Acquired on the Natus RetCam Envision · infant wide-field fundus photograph: 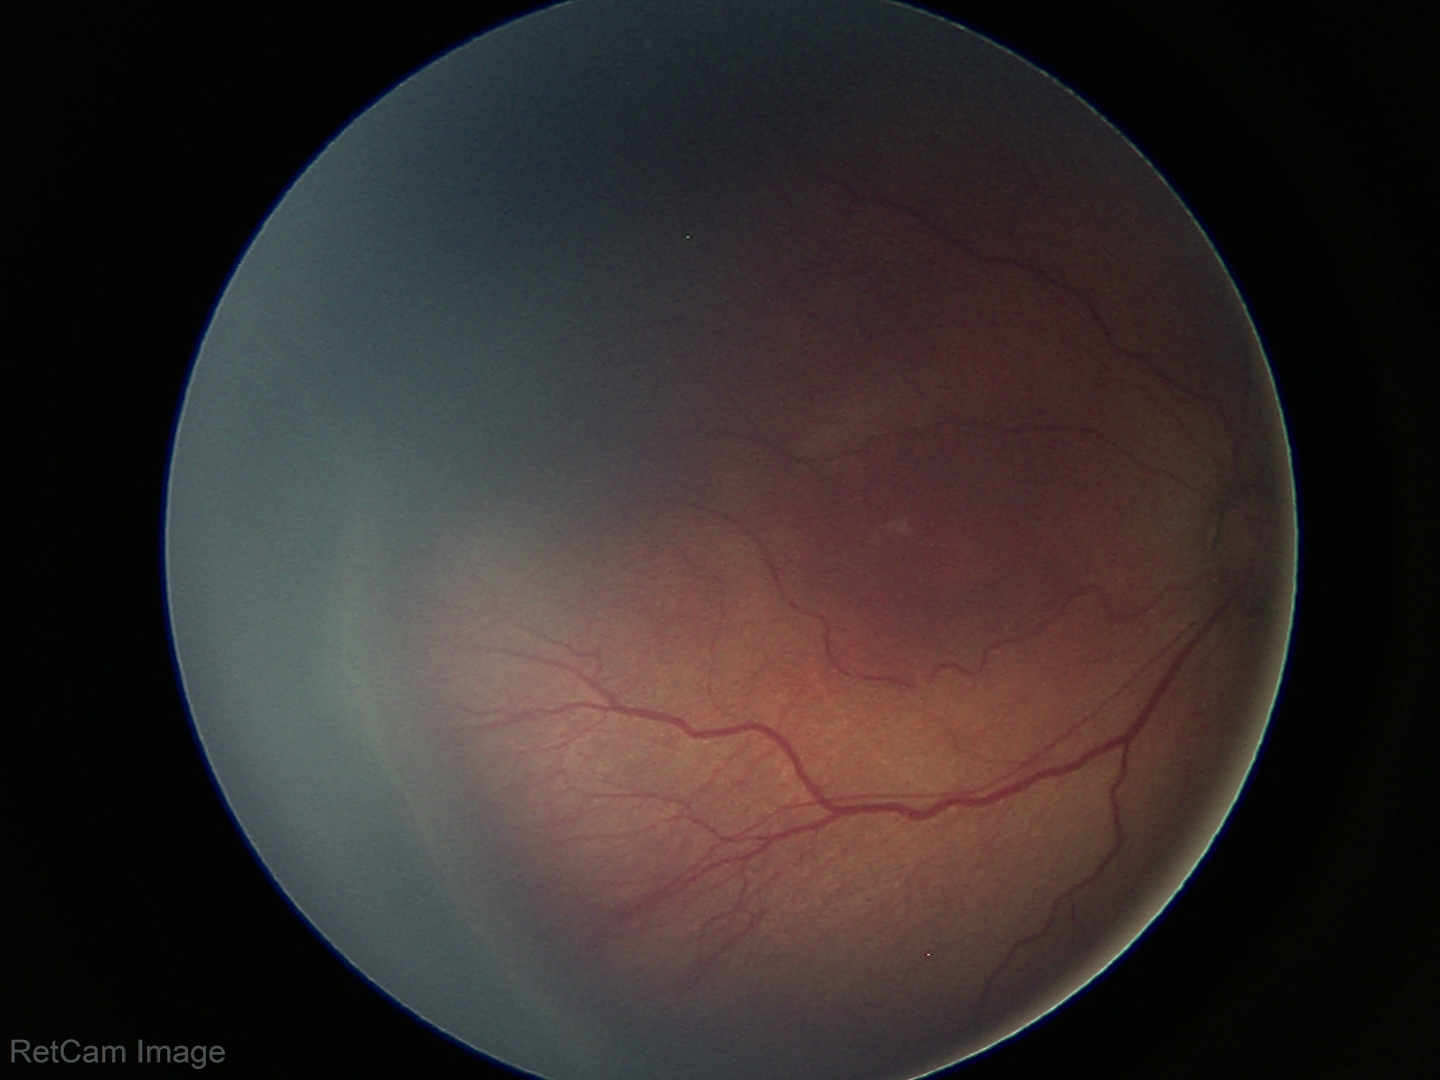
Screening series with ROP stage 3 — ridge with extraretinal fibrovascular proliferation.
Without plus disease.